Ultra-widefield fundus photograph · FOV: 200 degrees:
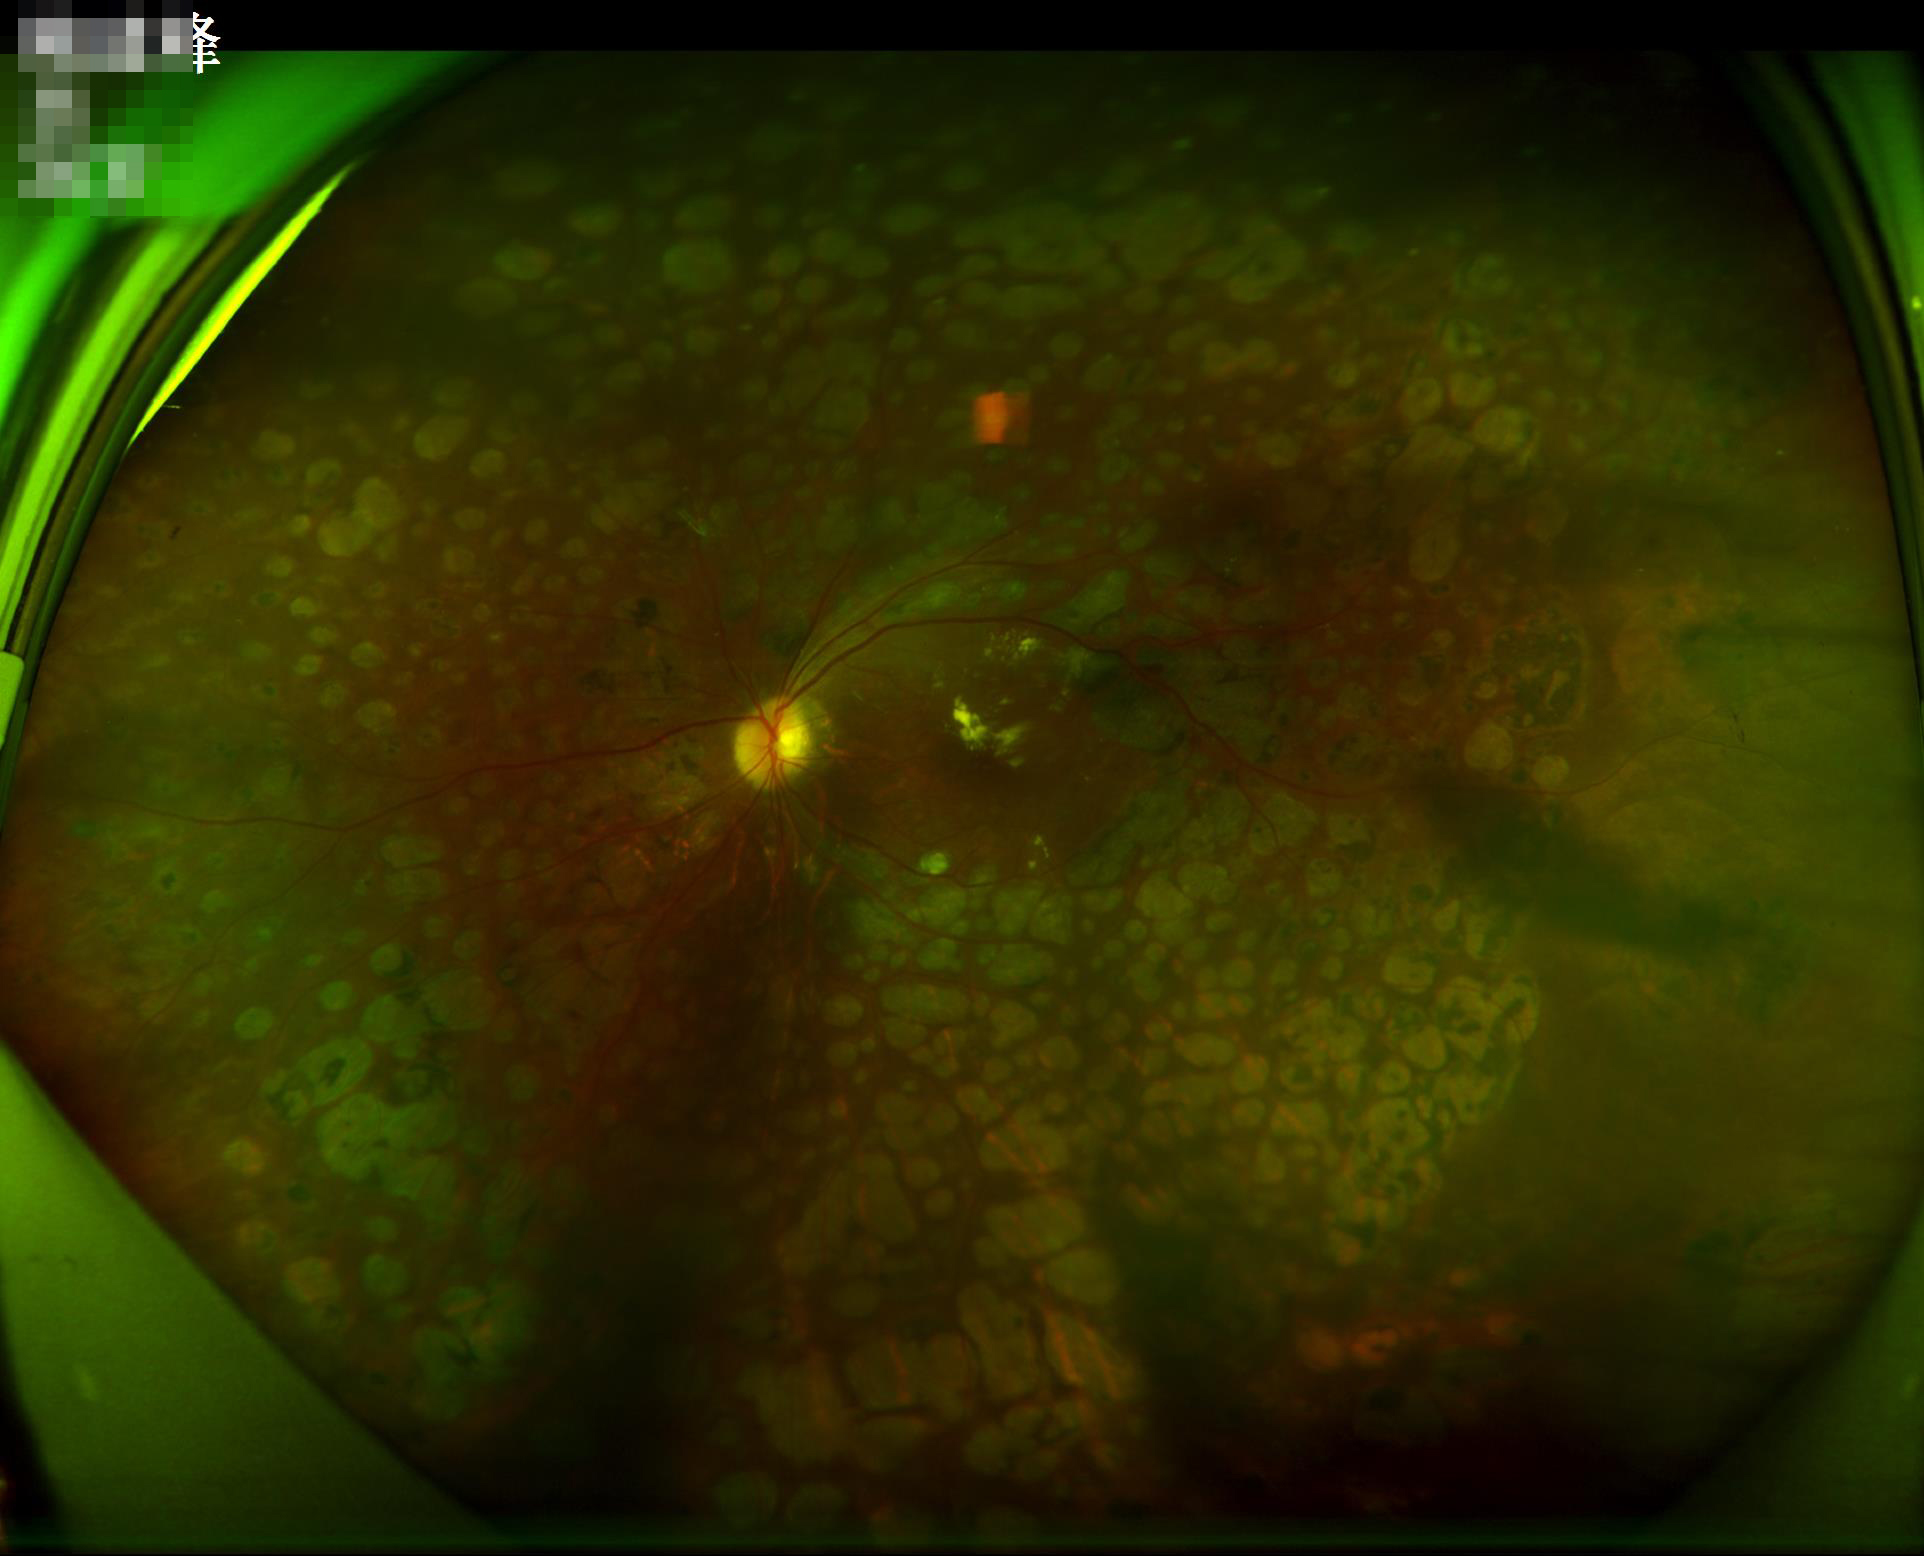
Illumination is even.
Overall image quality is good.
Poor dynamic range.